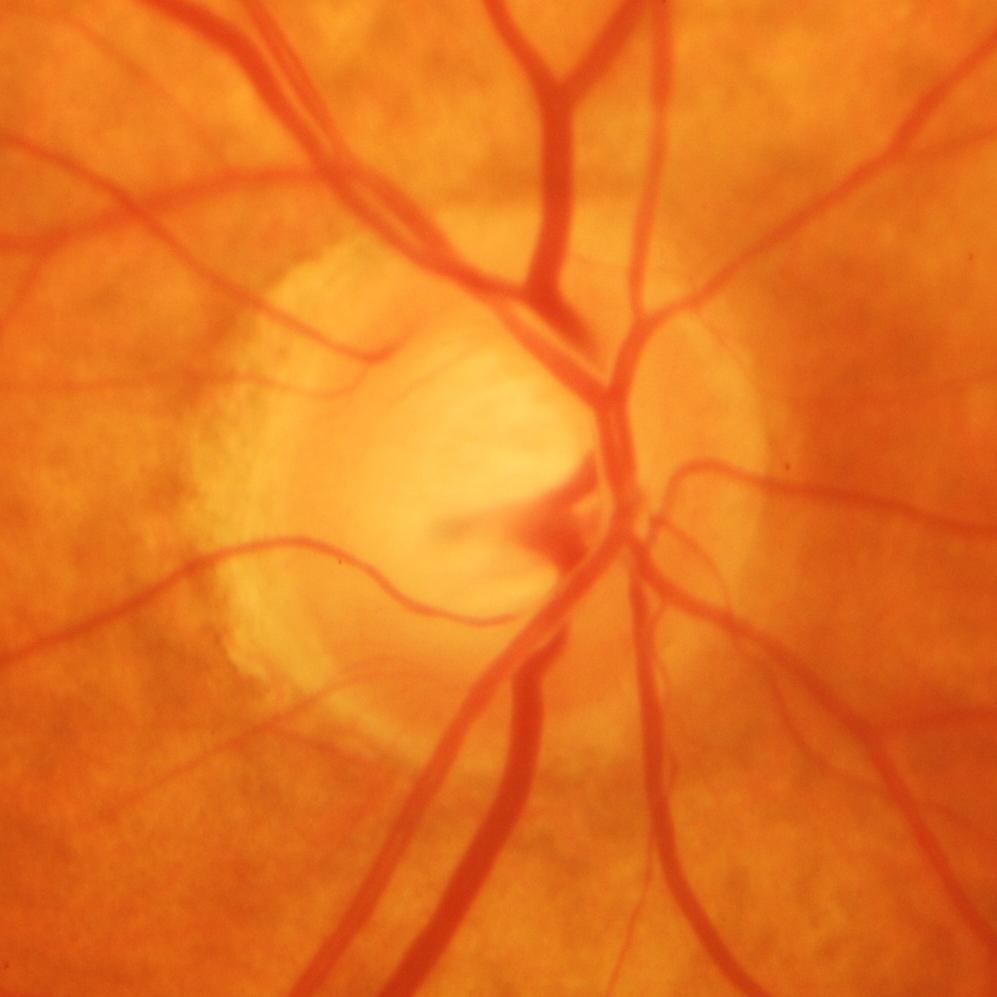 Glaucoma status: present.